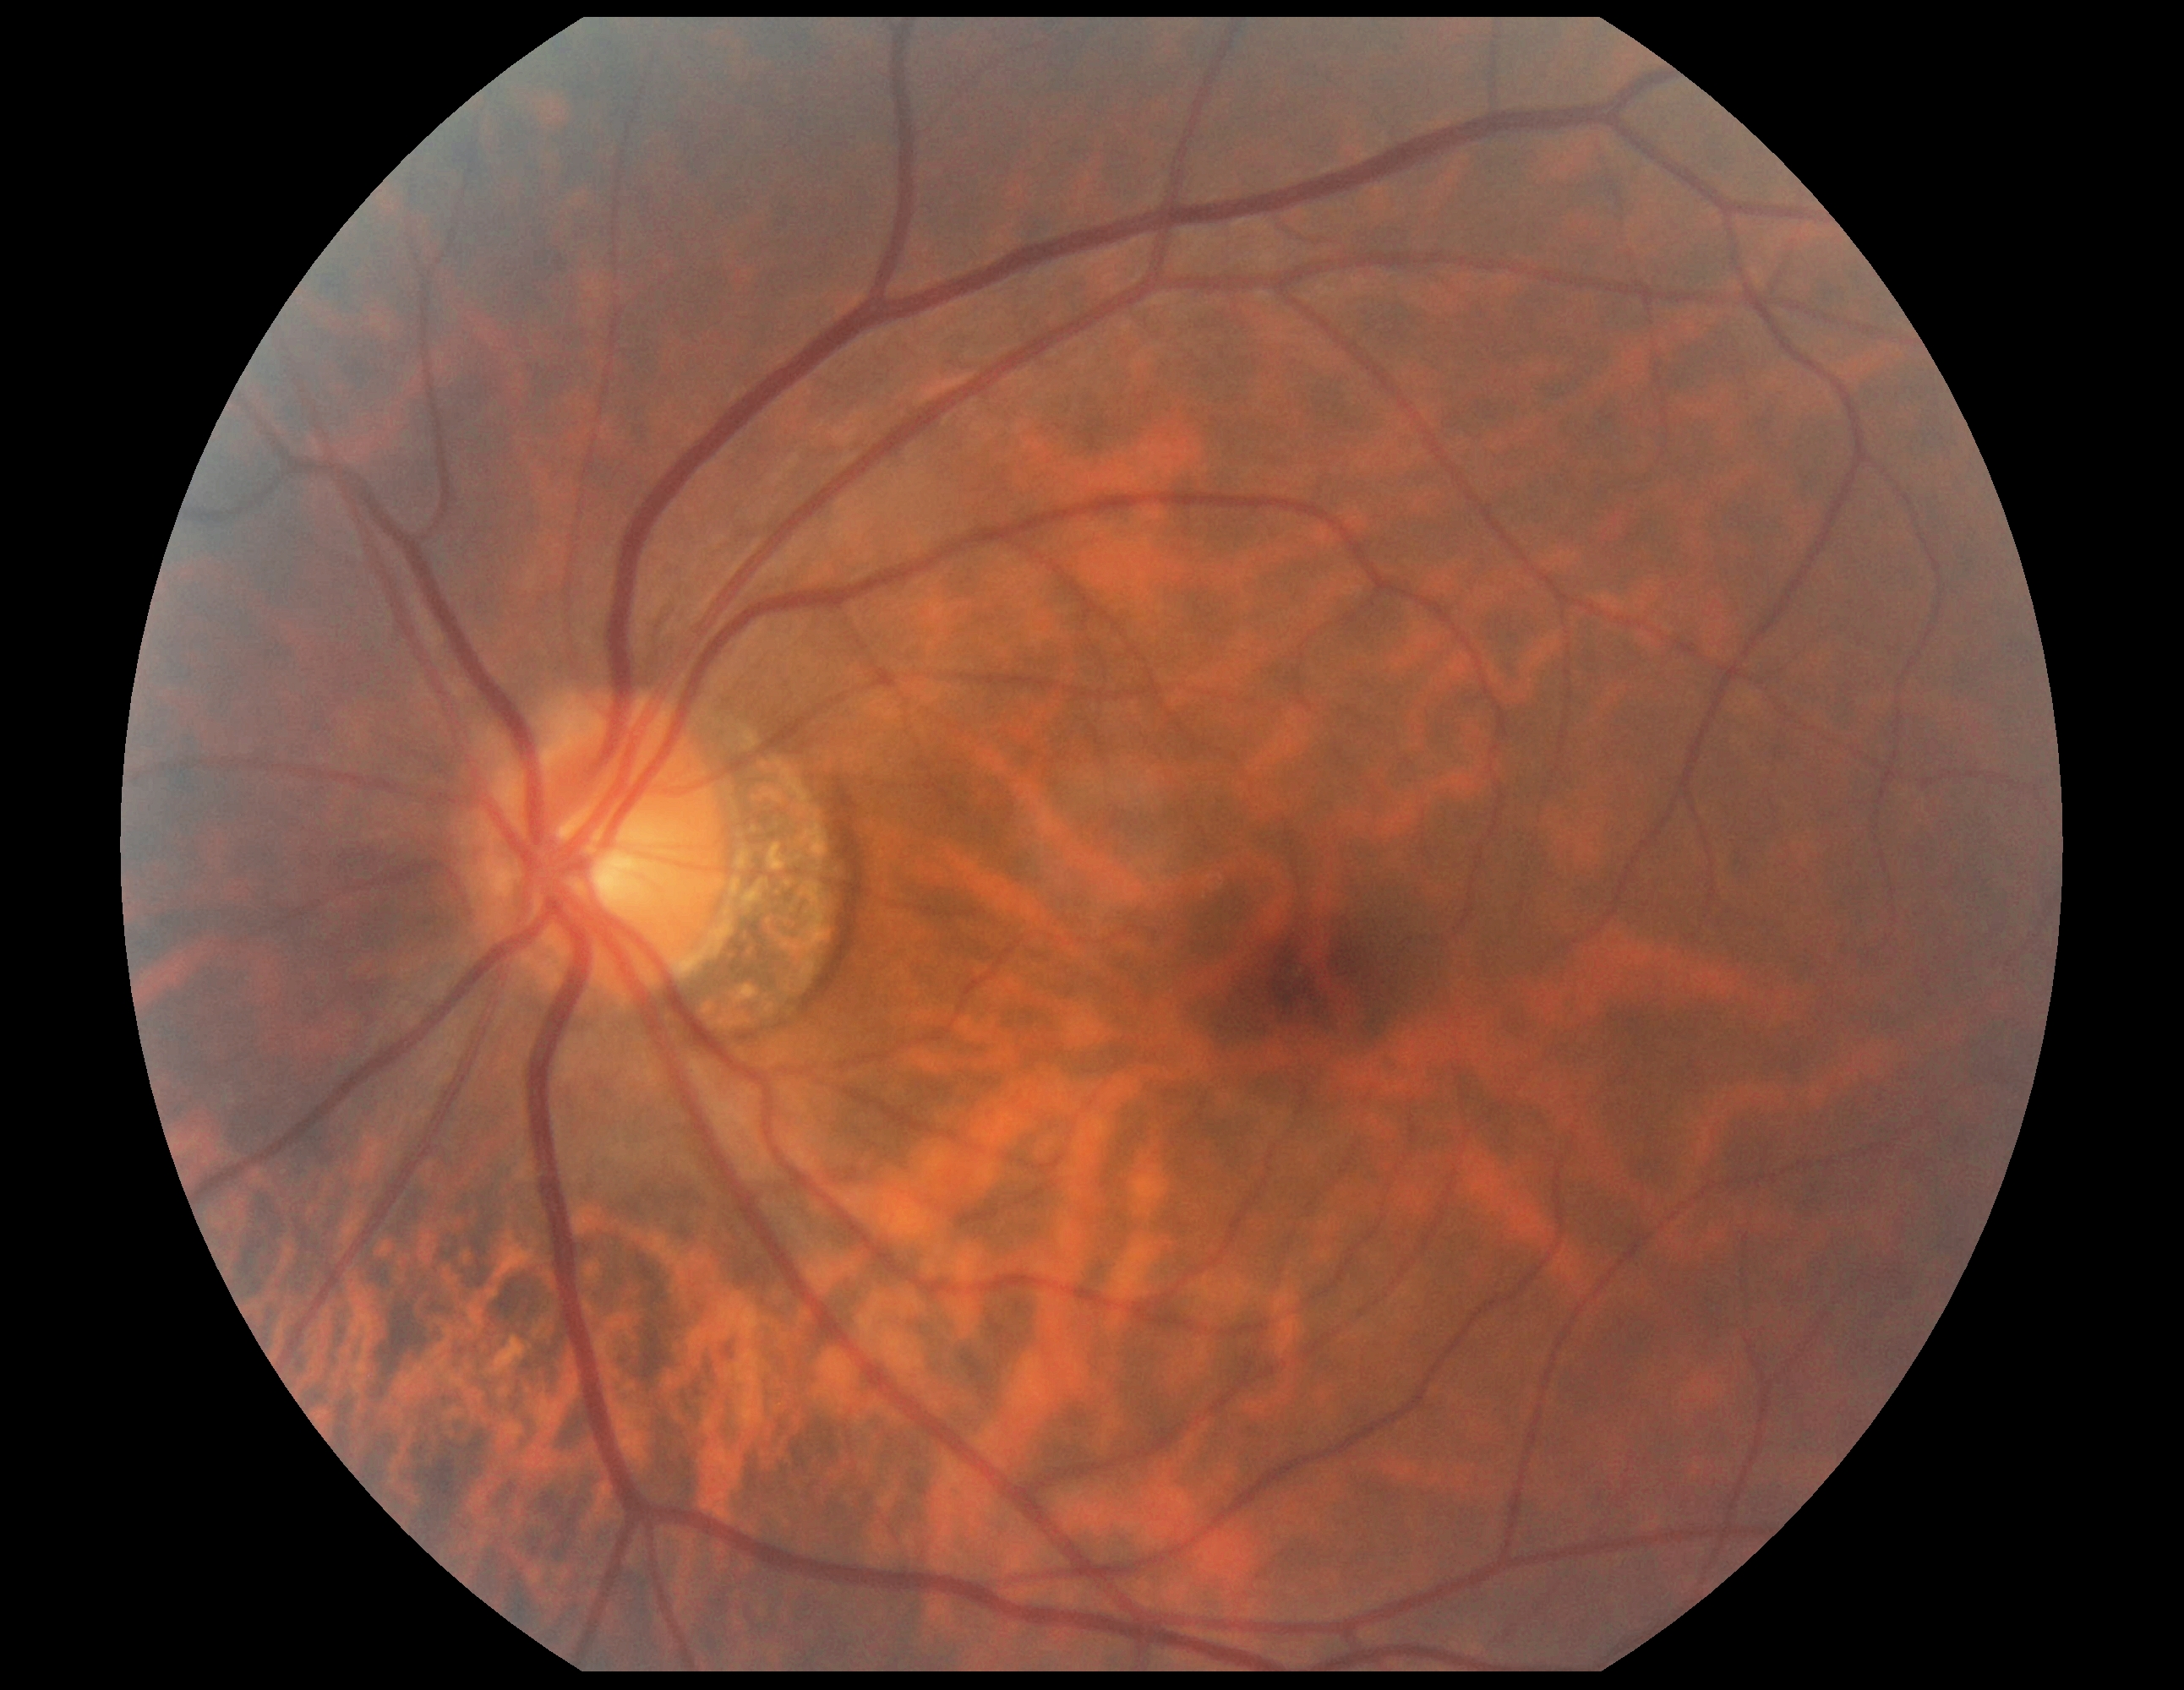 {
  "dr_grade": "no apparent retinopathy (0)"
}